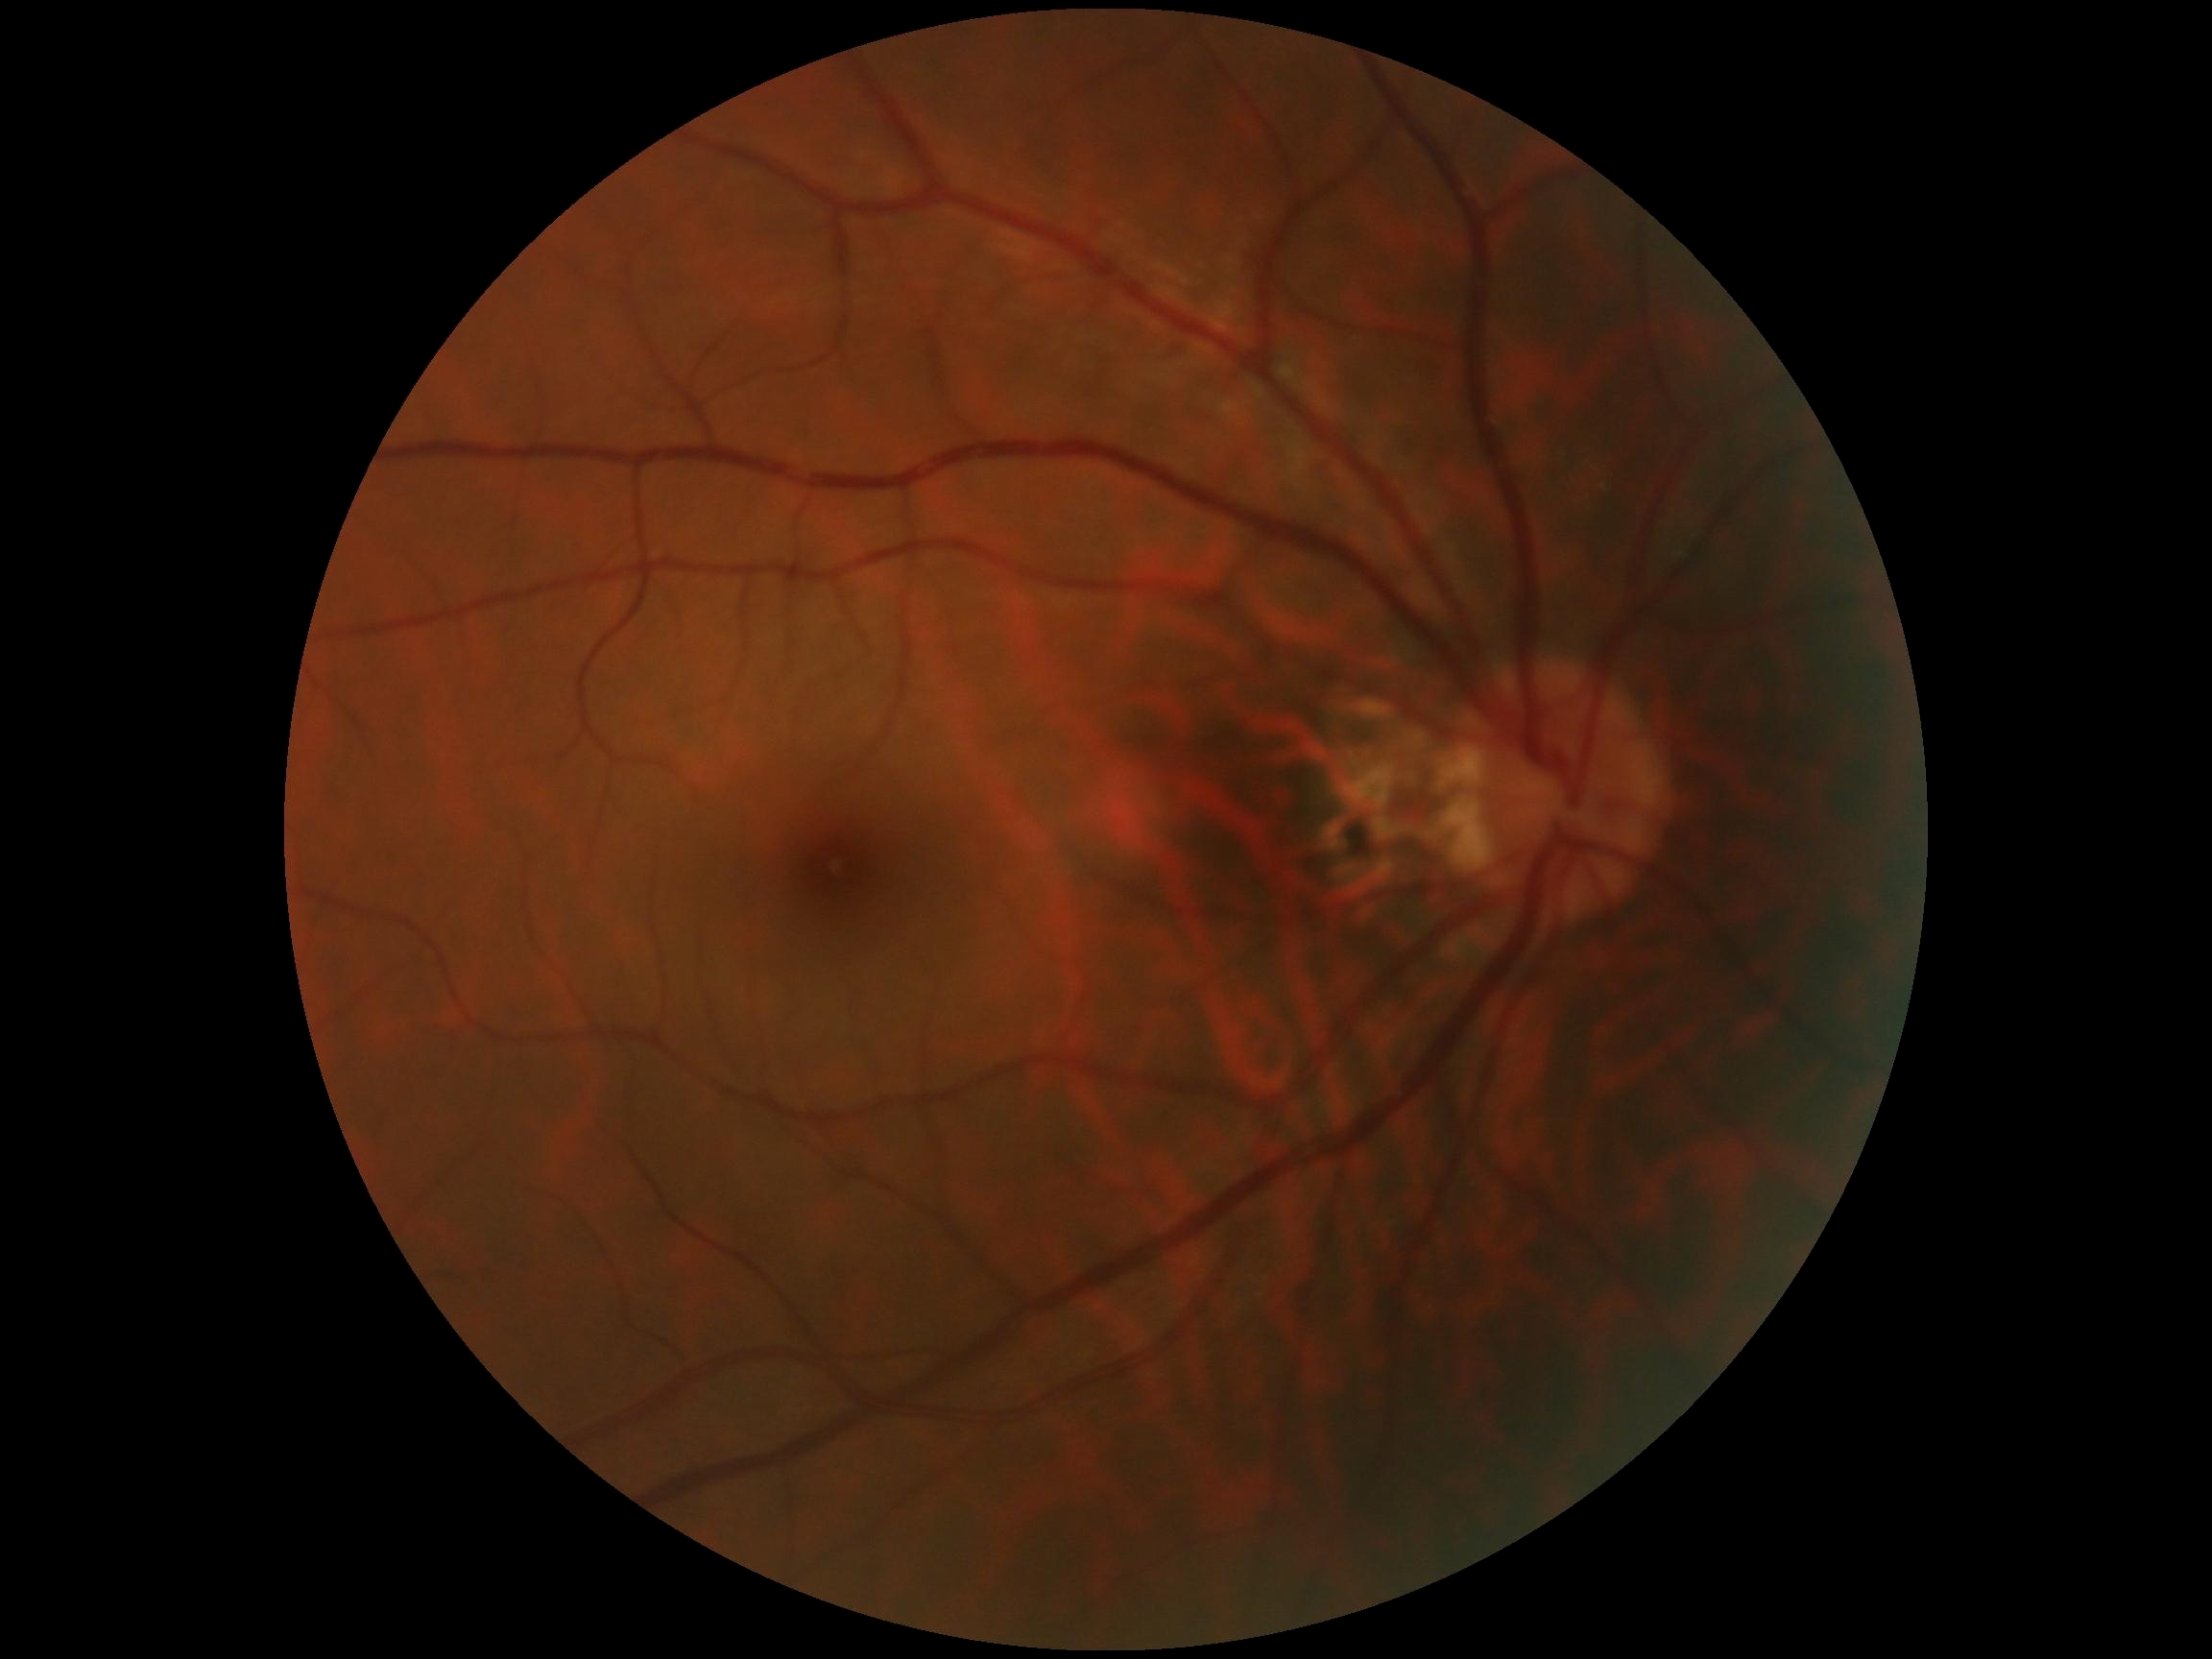
diabetic retinopathy = no apparent retinopathy (grade 0).